Camera: NIDEK AFC-230 — 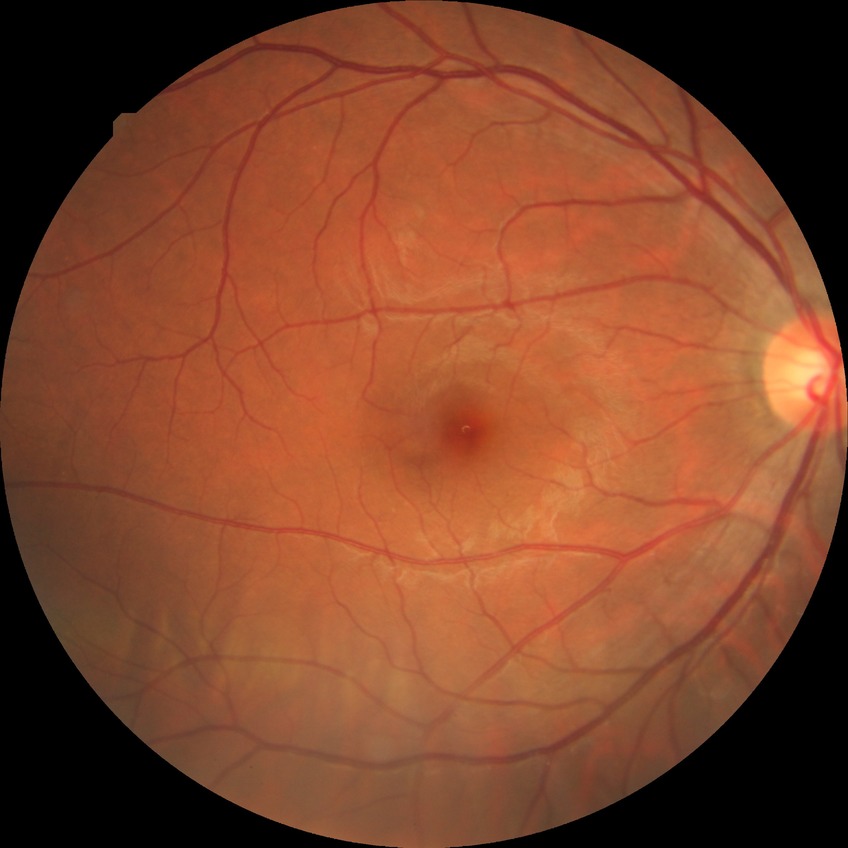 diabetic retinopathy (DR) = NDR (no diabetic retinopathy).